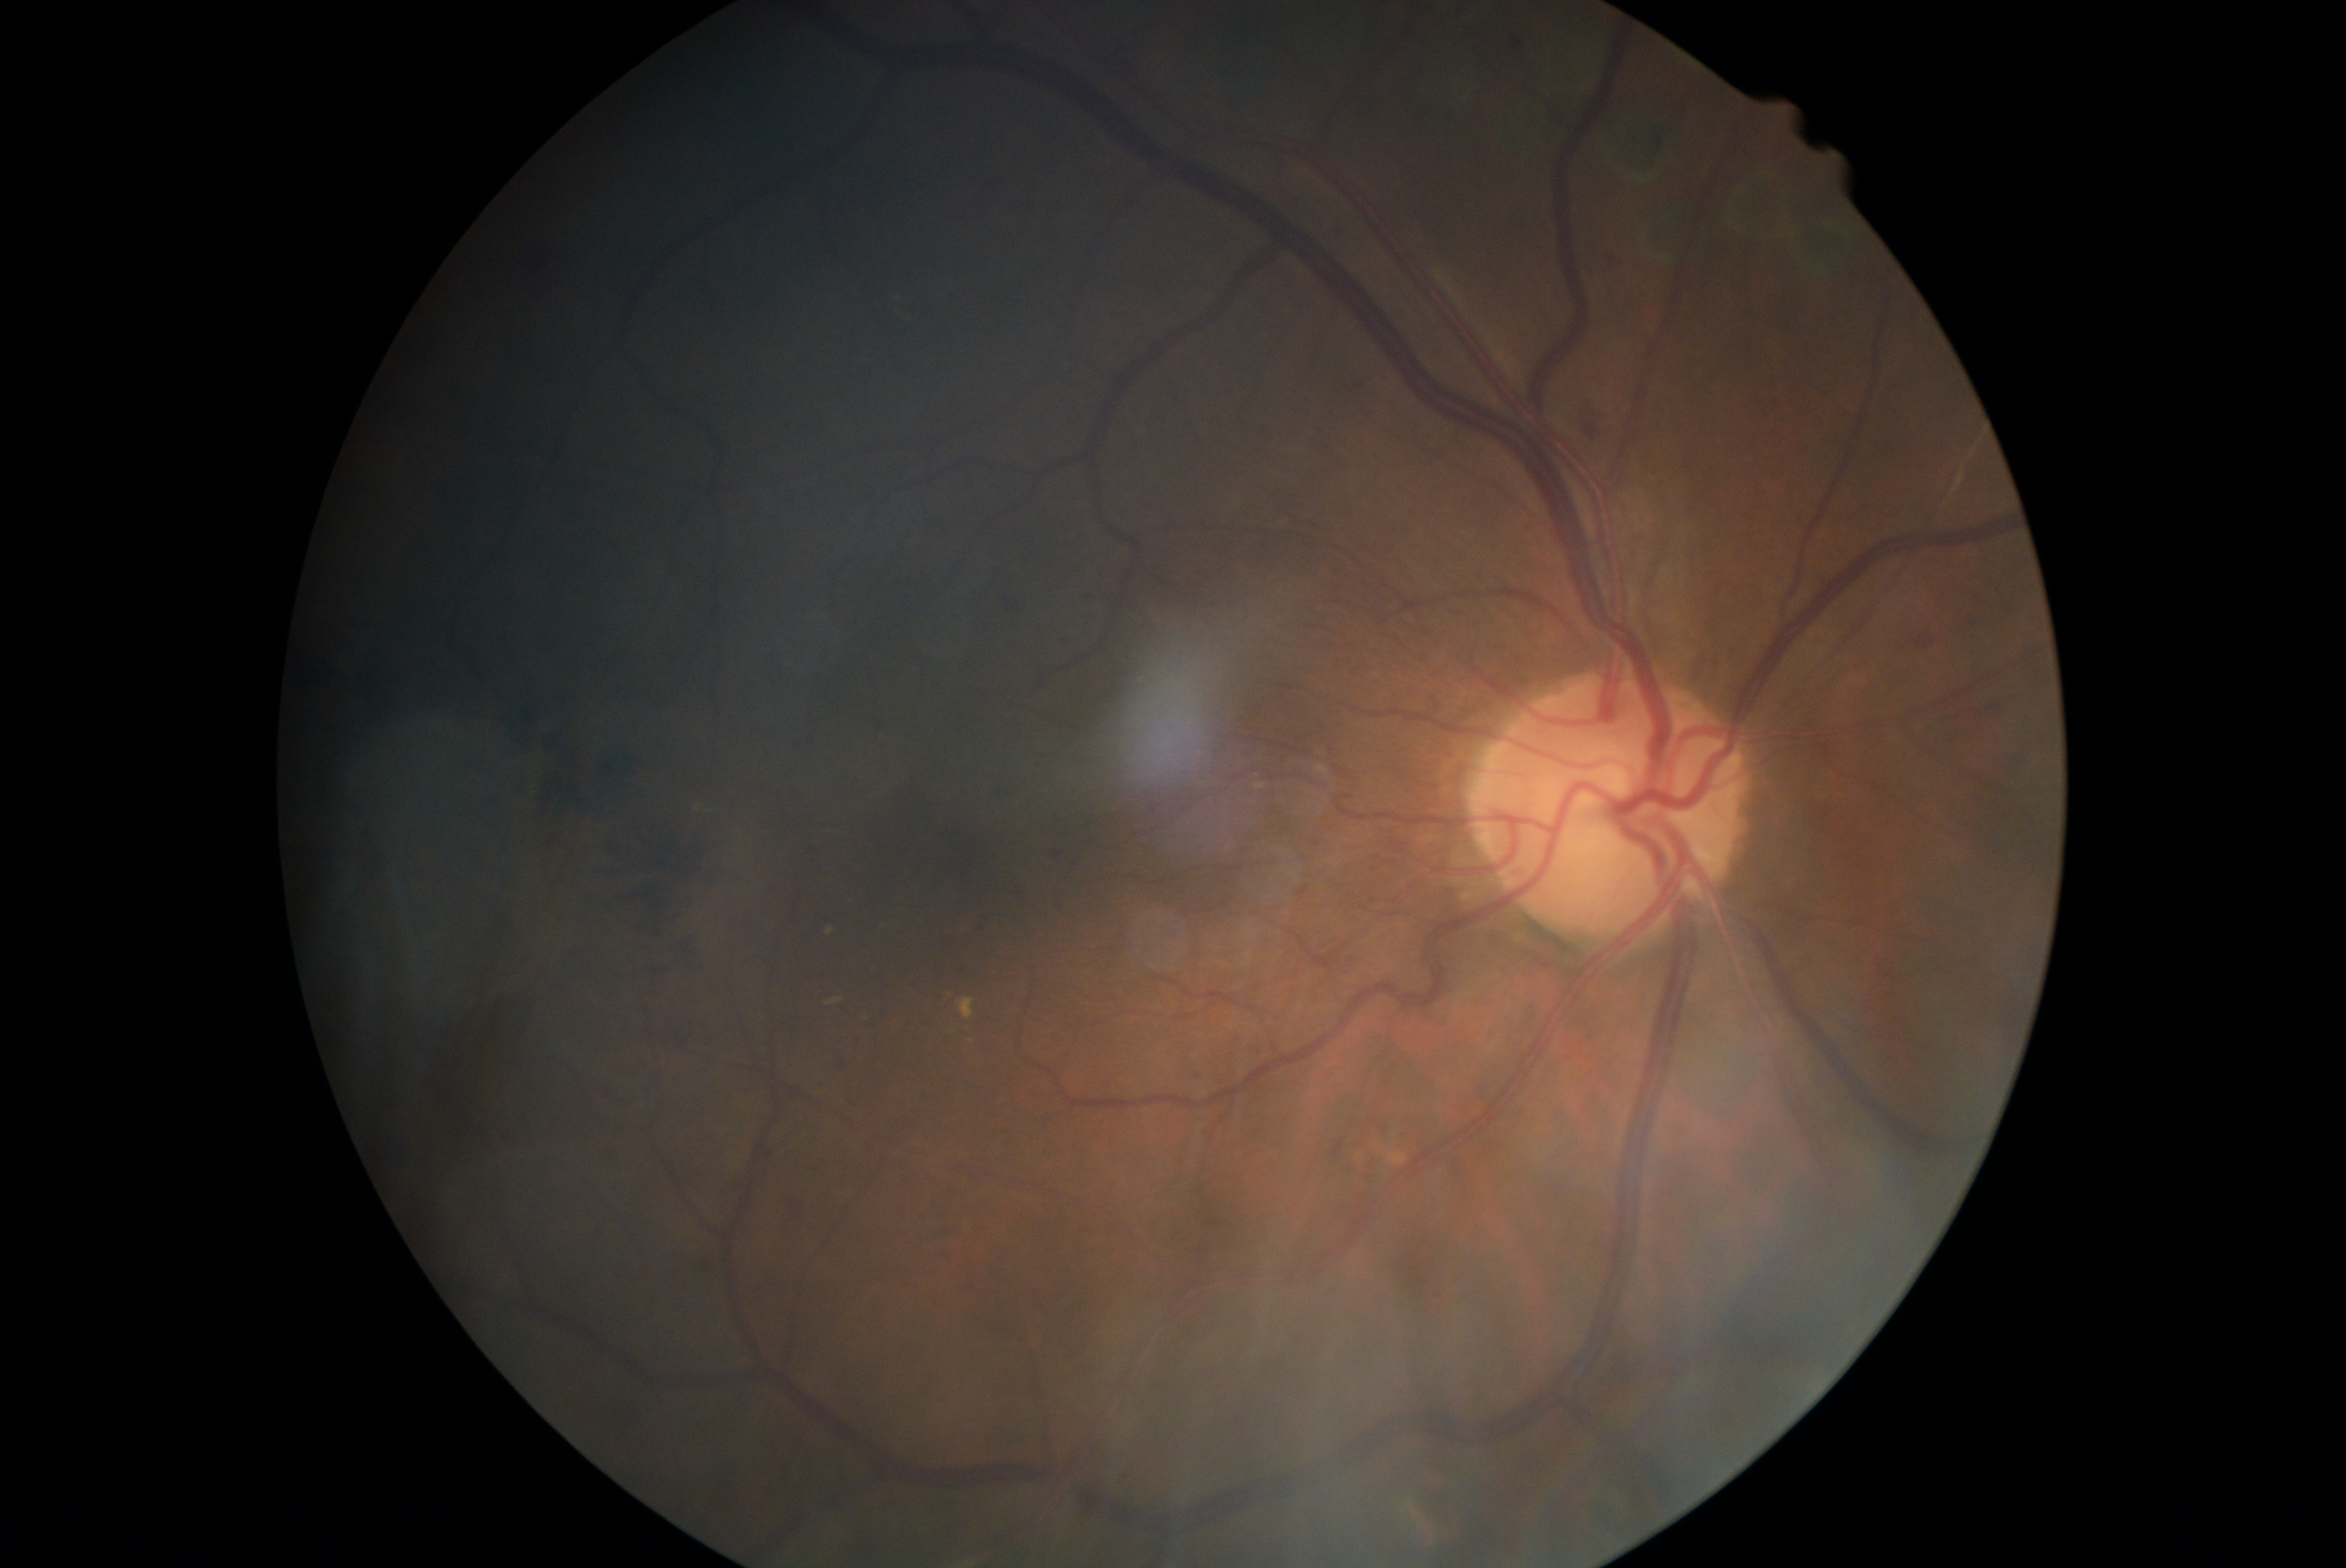

Diabetic retinopathy (DR) is moderate non-proliferative diabetic retinopathy (grade 2).